1240 by 1240 pixels · pediatric retinal photograph (wide-field) · 100° field of view (Phoenix ICON): 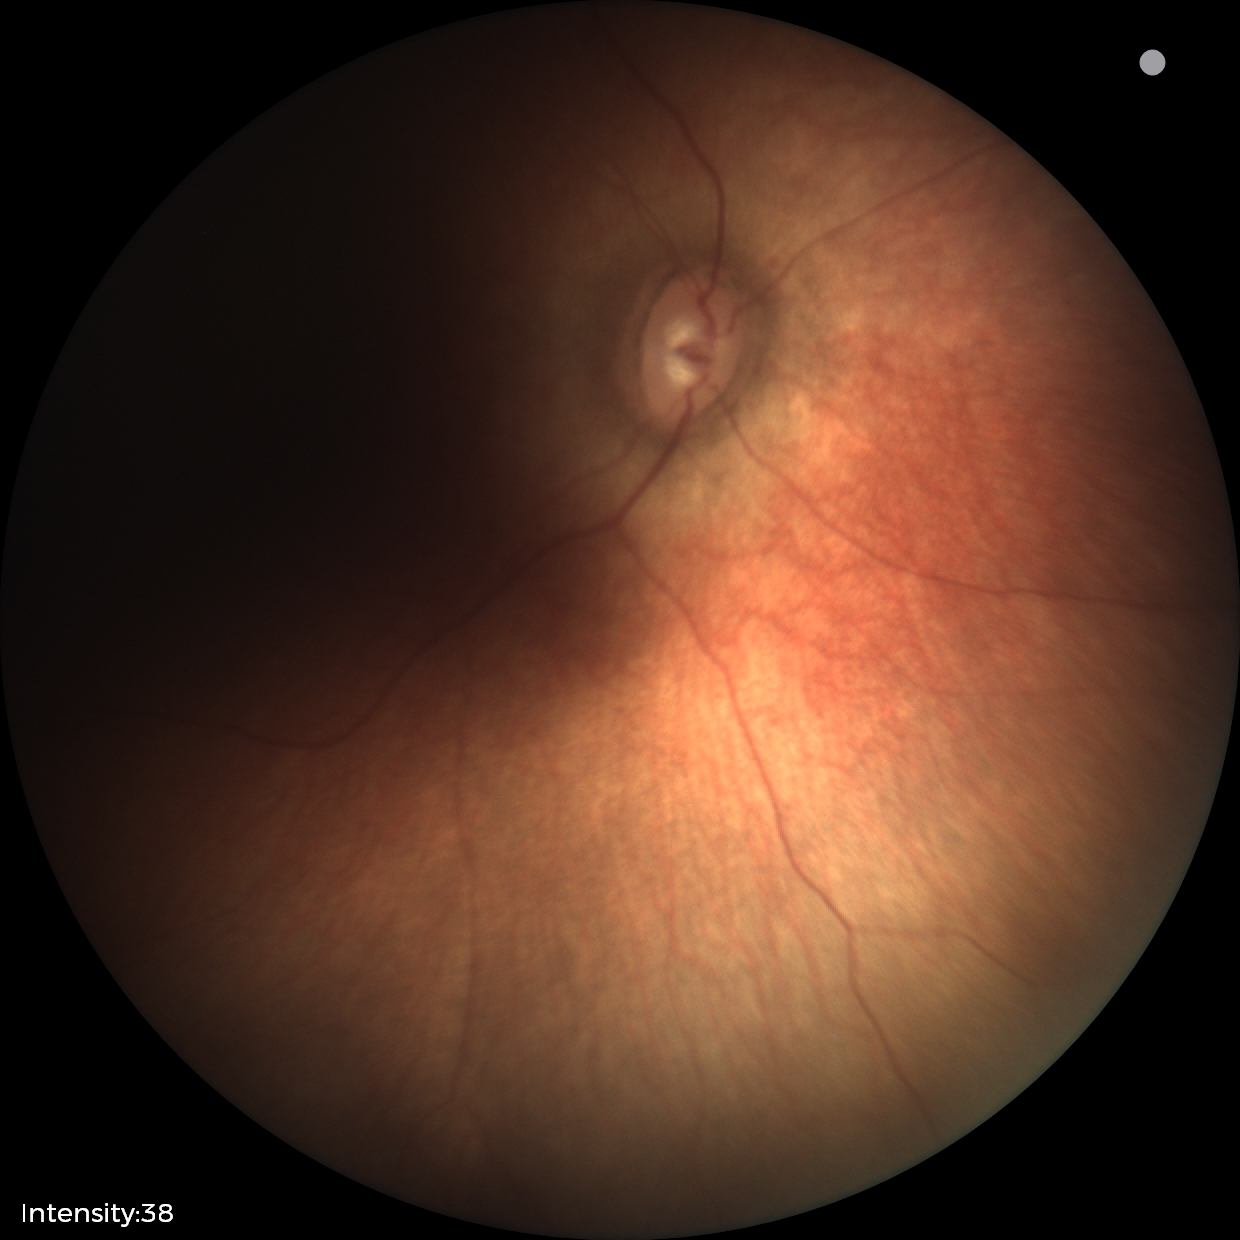
Examination with physiological retinal findings.